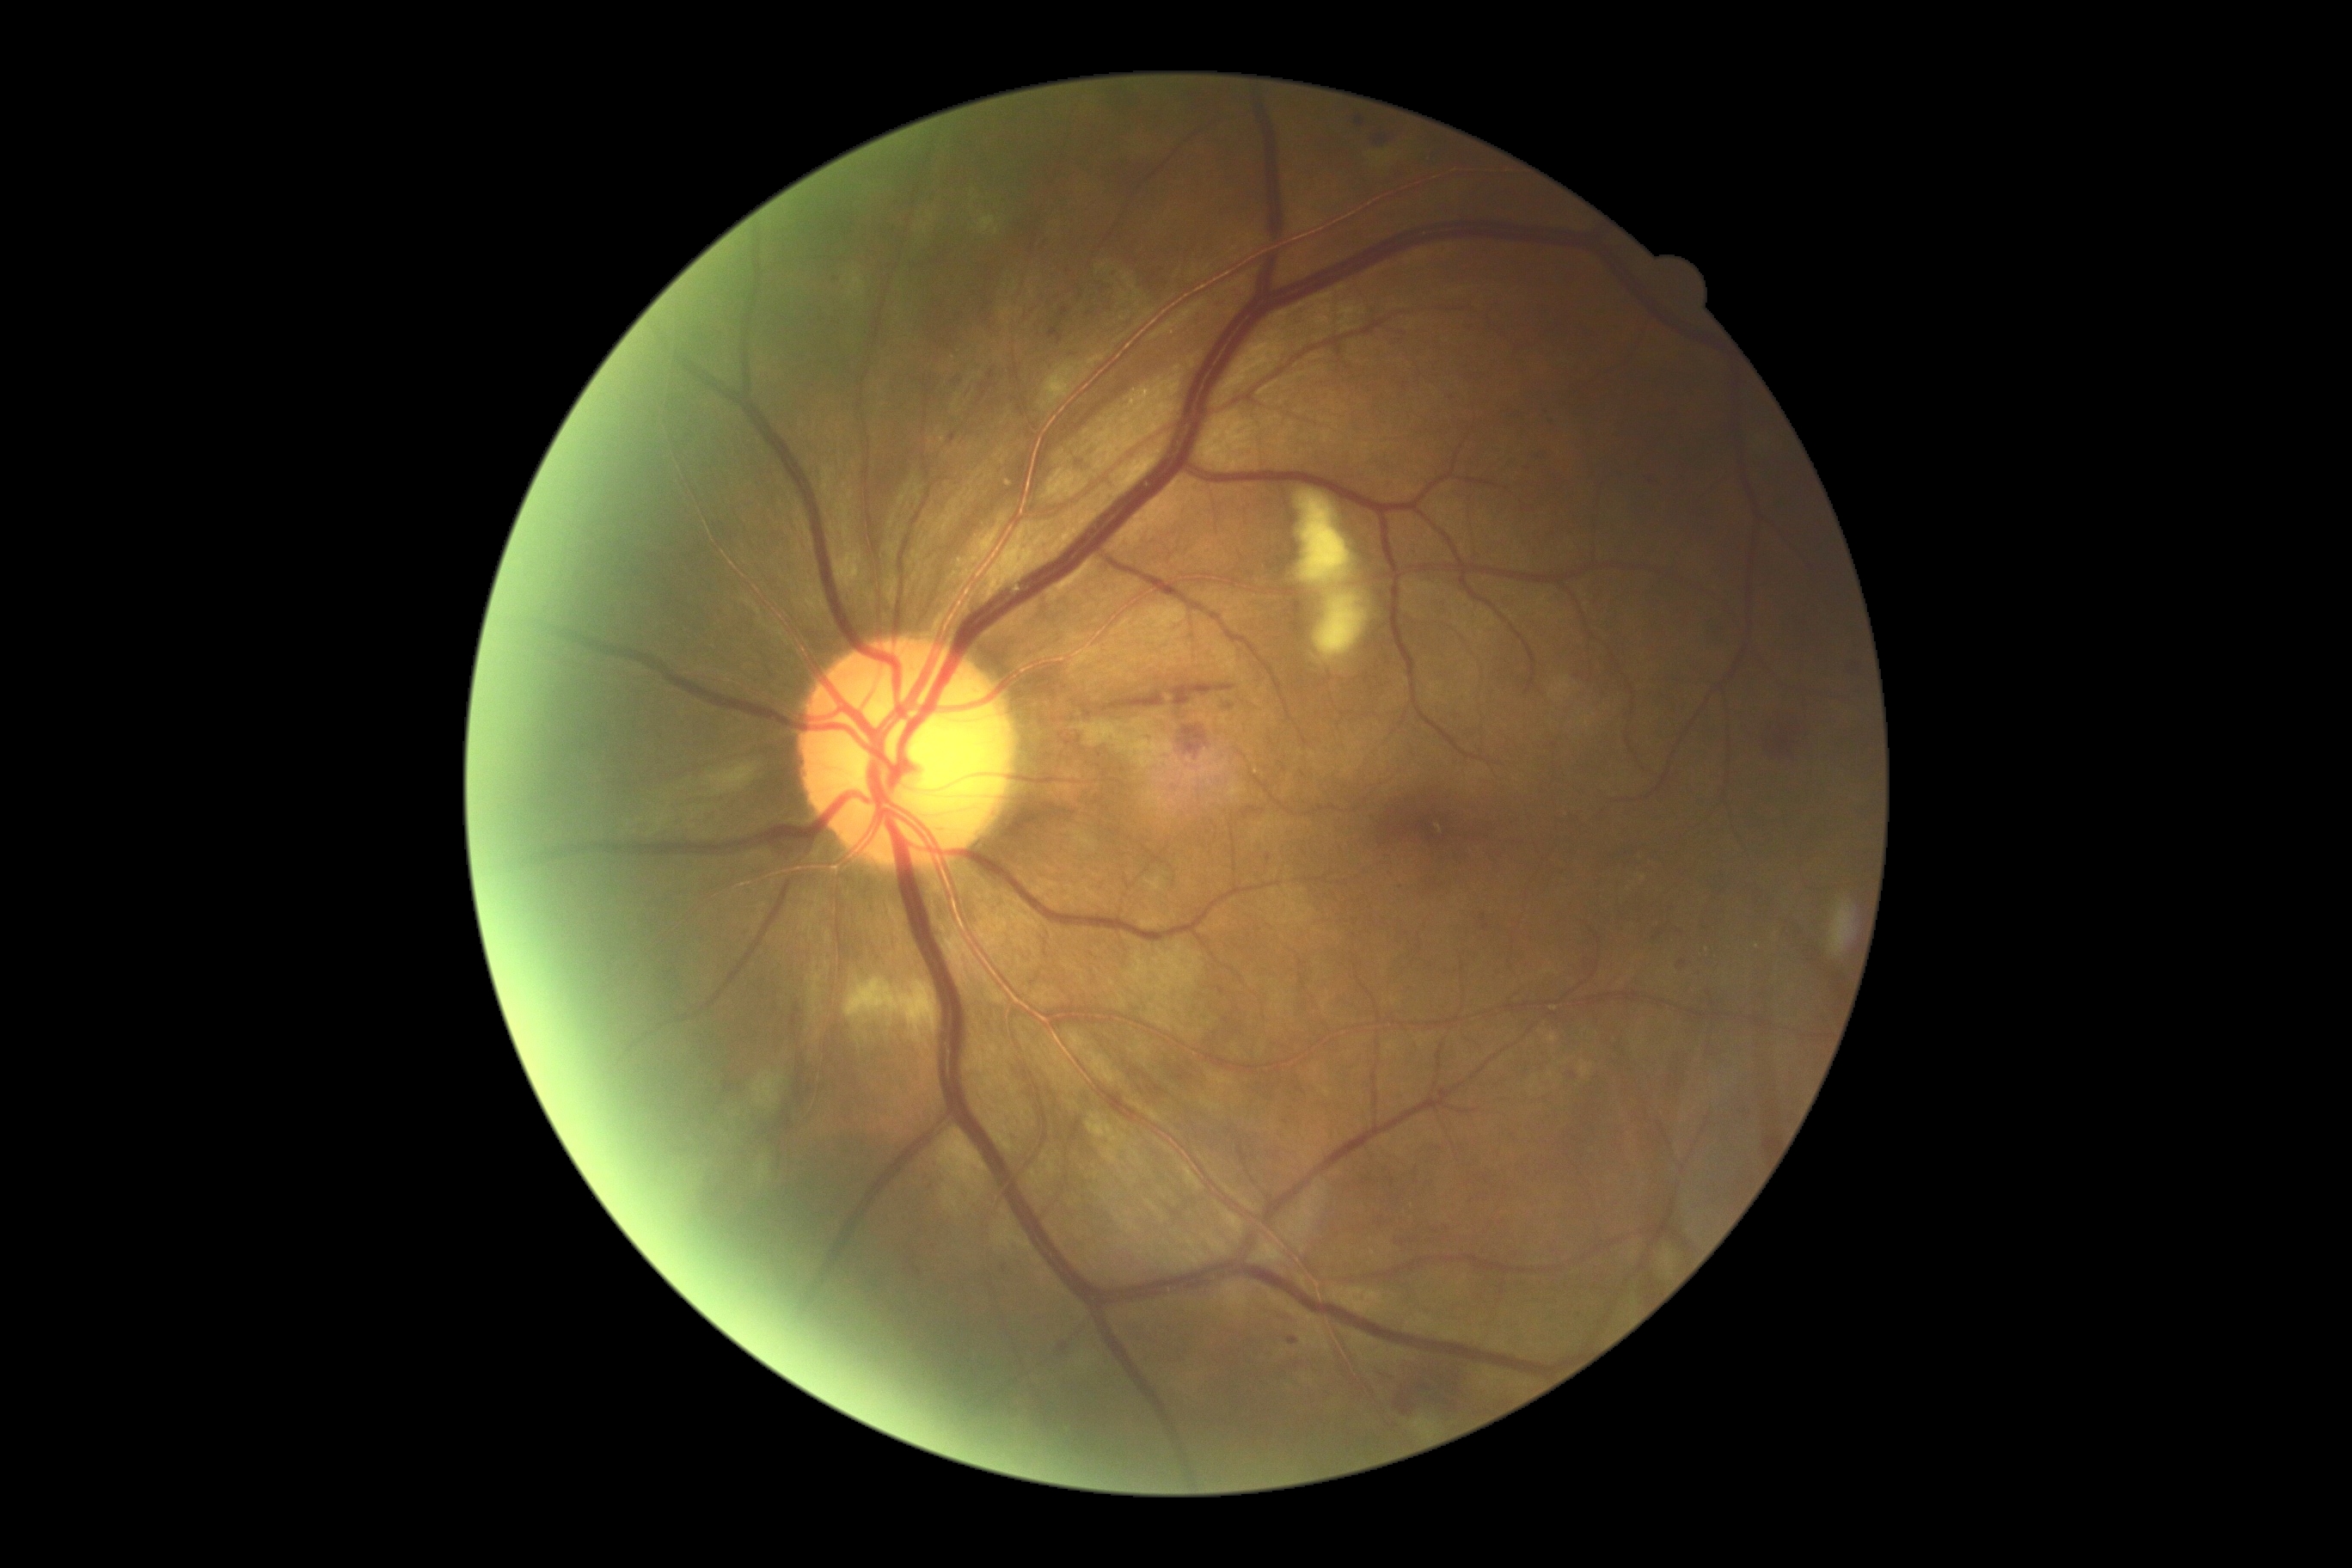 Diabetic retinopathy (DR): grade 2
Representative lesions:
hemorrhages (HEs): [1172, 685, 1235, 709] | [1767, 704, 1815, 761] | [988, 371, 995, 381] | [1180, 726, 1208, 756] | [1375, 135, 1390, 145] | [977, 384, 993, 407] | [1390, 1363, 1474, 1418] | [1103, 692, 1165, 713]
microaneurysms (MAs) (more not shown): [1481, 914, 1490, 931] | [1356, 116, 1366, 126] | [1058, 307, 1070, 319] | [912, 1266, 922, 1277] | [1048, 324, 1063, 345] | [1227, 704, 1235, 711] | [1218, 988, 1227, 995] | [1289, 1338, 1299, 1345] | [1677, 960, 1687, 969] | [1058, 1342, 1070, 1356] | [948, 432, 957, 444]
Small MAs near Point(1857, 666) | Point(1090, 315) | Point(1443, 1089) | Point(1578, 676) | Point(1005, 1270) | Point(1574, 1077)
hard exudates (EXs): [1638, 874, 1646, 883]
Small EXs near Point(1630, 974) | Point(1758, 946) | Point(1629, 889) | Point(1708, 950)
soft exudates (SEs): [1087, 1113, 1144, 1168] | [1412, 1418, 1436, 1438] | [850, 278, 866, 297] | [1314, 591, 1369, 665] | [1039, 364, 1086, 410] | [1299, 491, 1352, 587] | [756, 1160, 771, 1187] | [1375, 150, 1390, 166] | [938, 1129, 988, 1197] | [845, 977, 938, 1043] | [752, 1072, 785, 1112] | [979, 216, 996, 233] | [1082, 720, 1175, 771] | [695, 761, 749, 795]